Wide-field contact fundus photograph of an infant; image size 640x480: 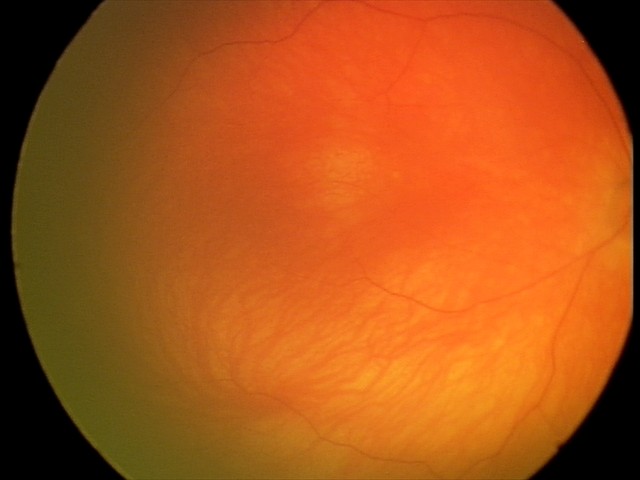 Assessment: no abnormal retinal findings.